Captured with the Phoenix ICON (100° field of view). Pediatric retinal photograph (wide-field).
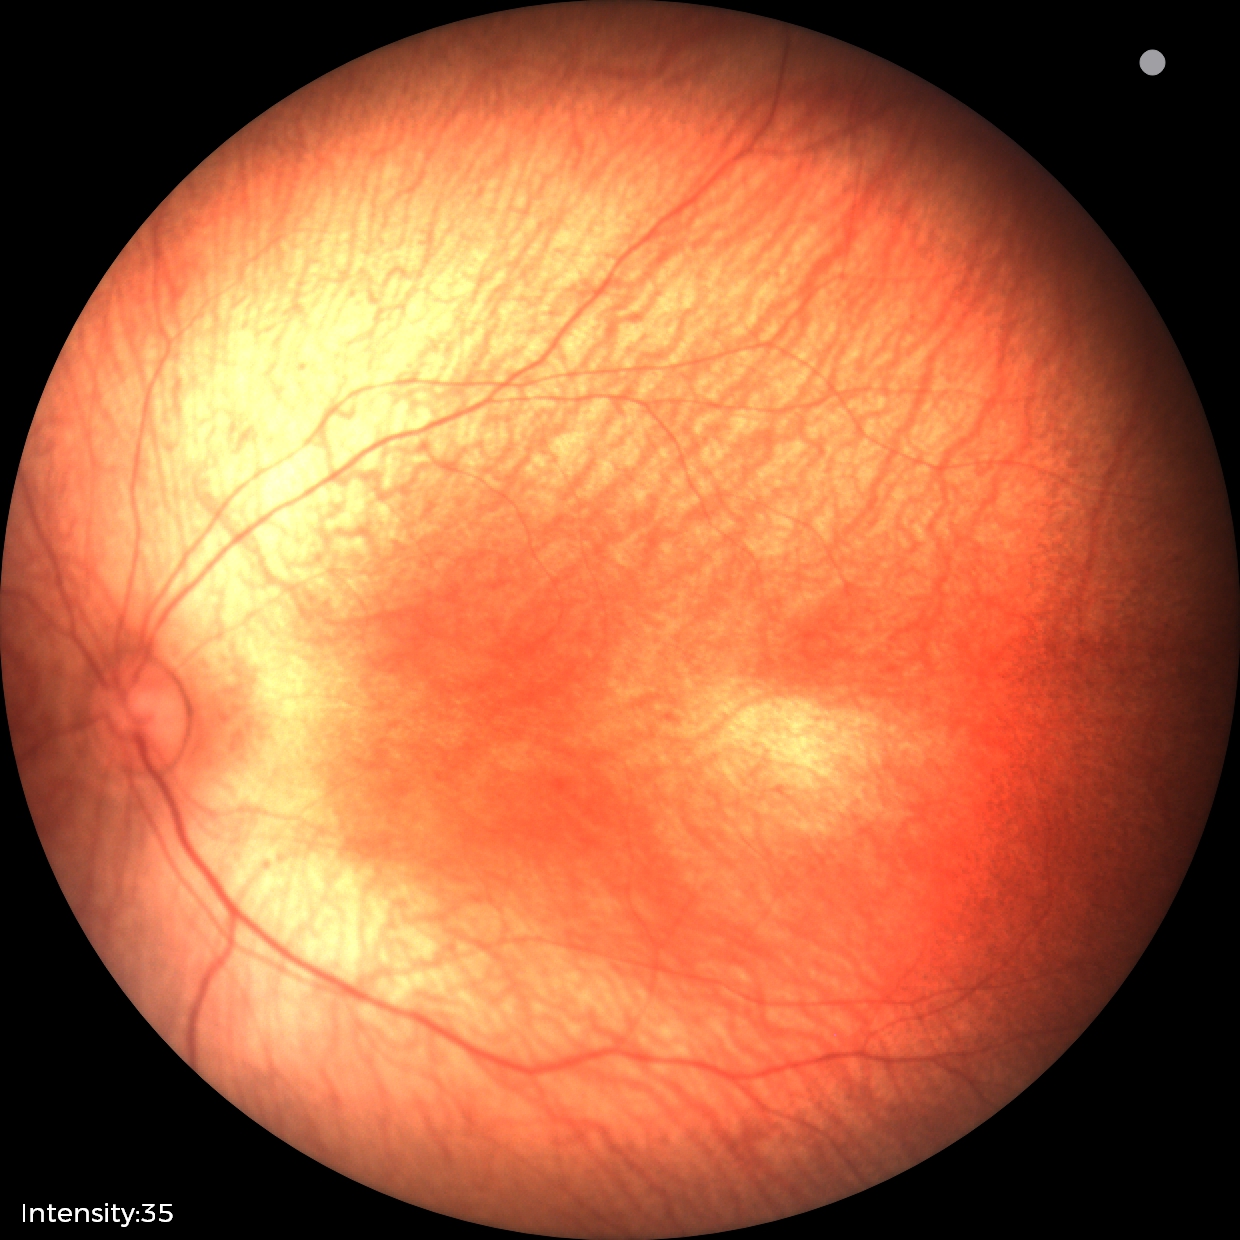
Finding: physiological appearance